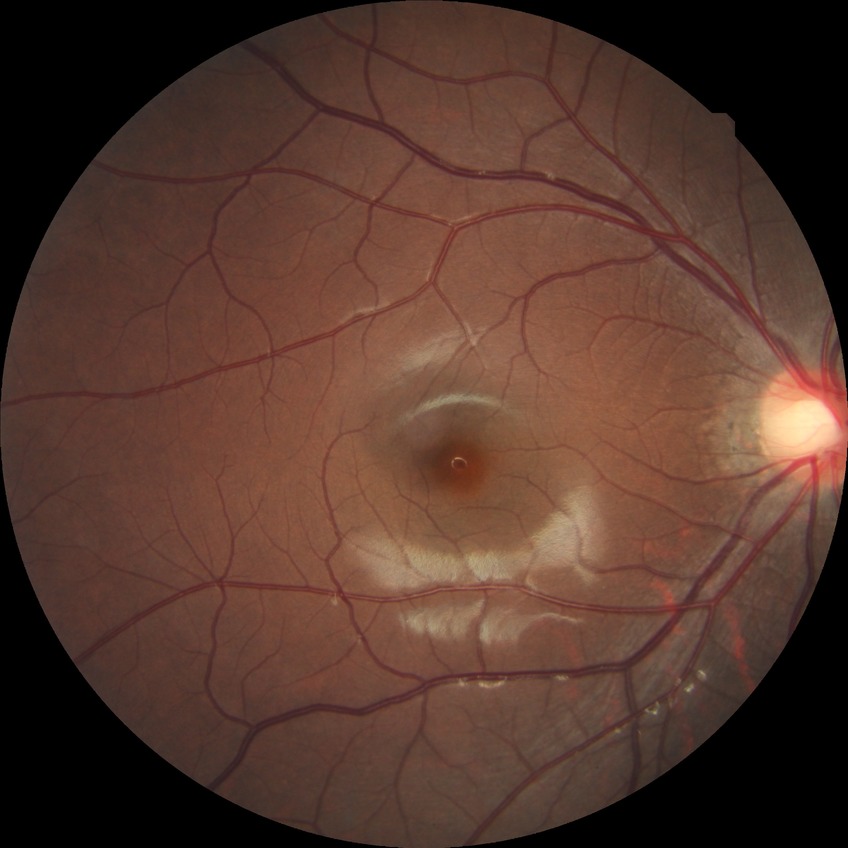 Diabetic retinopathy (DR): no diabetic retinopathy (NDR).